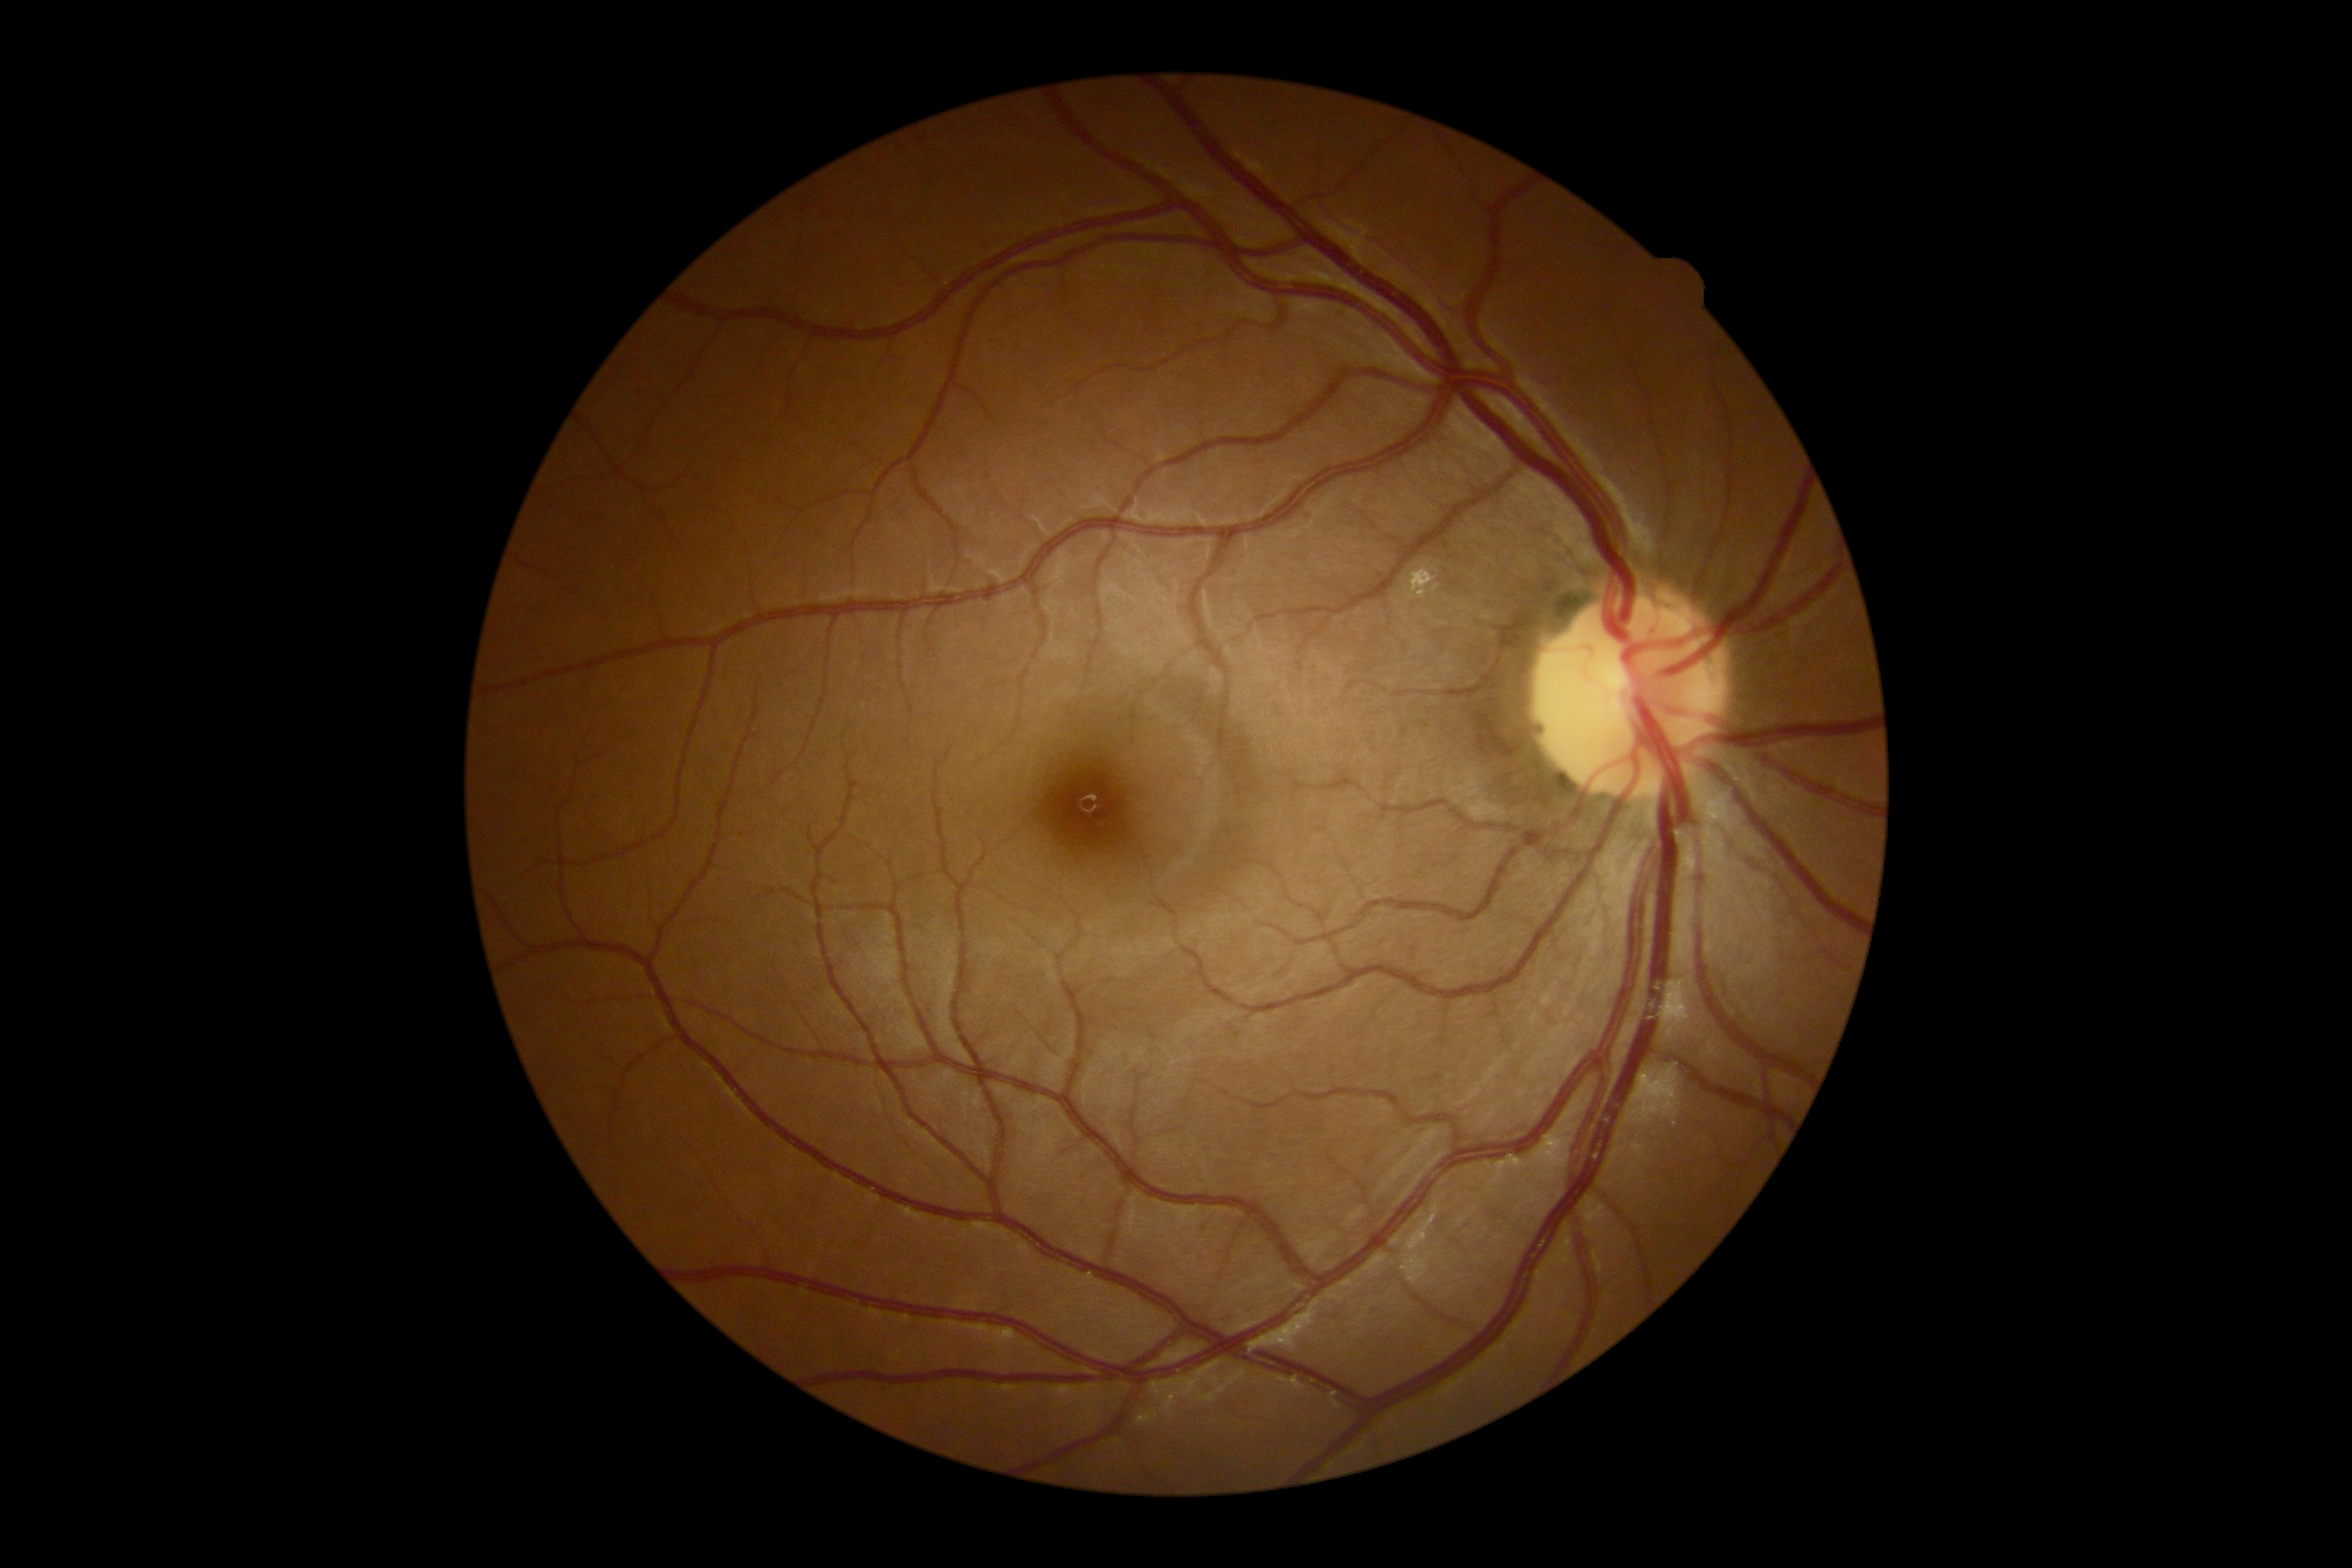

Diabetic retinopathy grade is 2. The retinopathy is classified as non-proliferative diabetic retinopathy.